Acquired on the Phoenix ICON · 1240x1240 · wide-field fundus photograph of an infant:
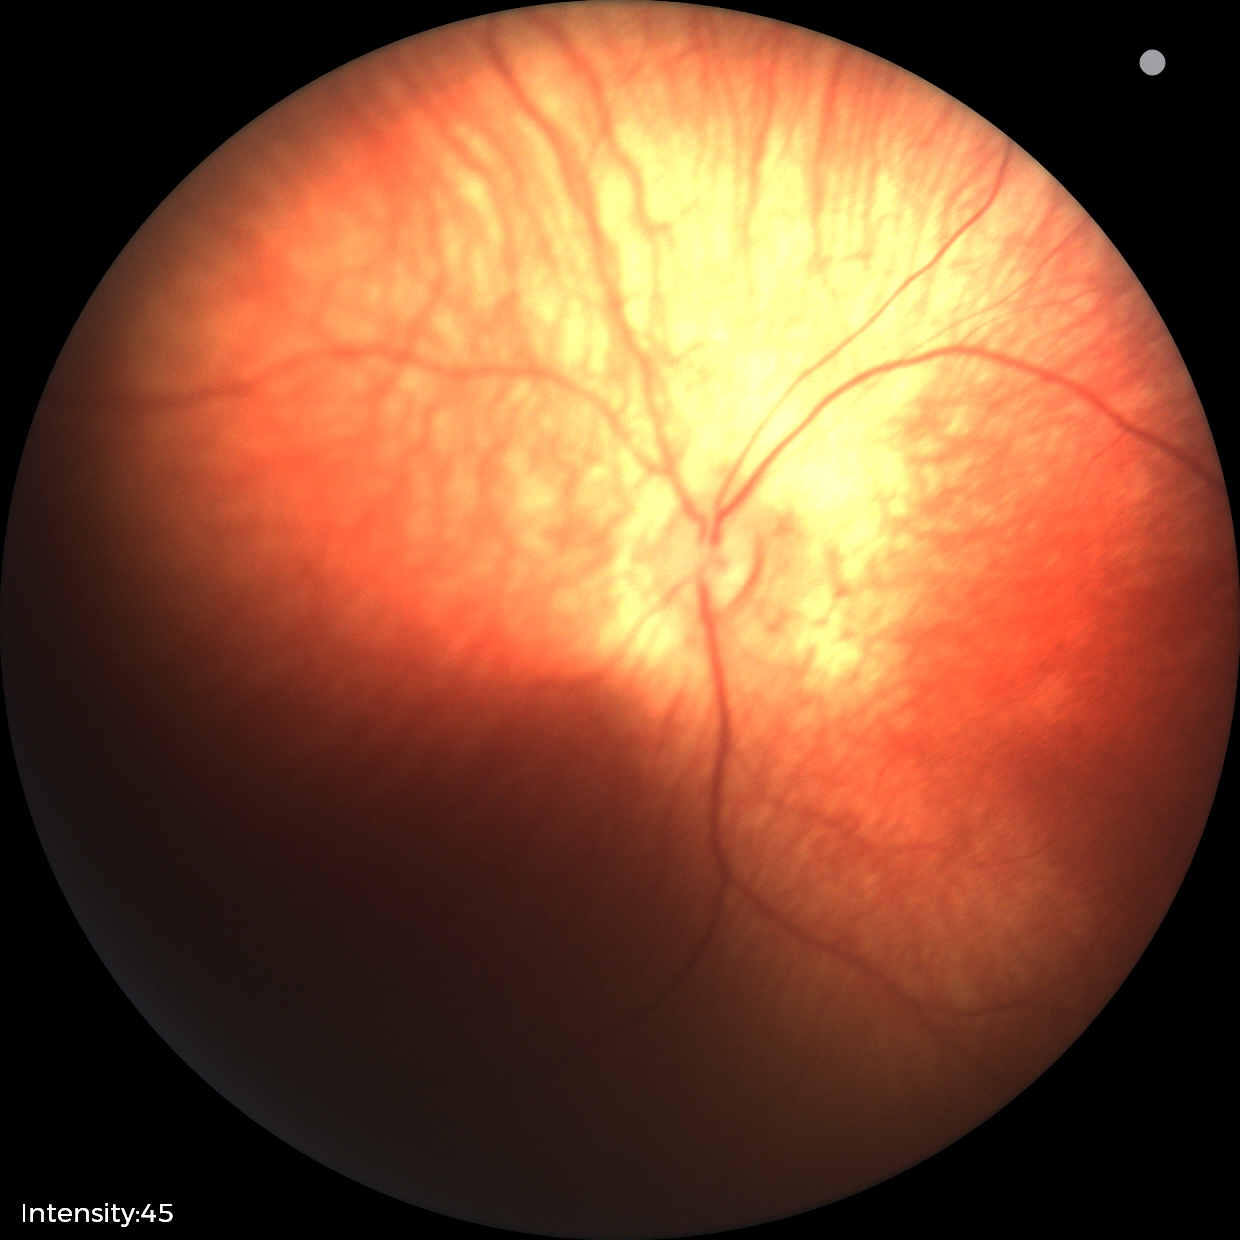 Screening examination diagnosed as physiological.